FOV: 45 degrees
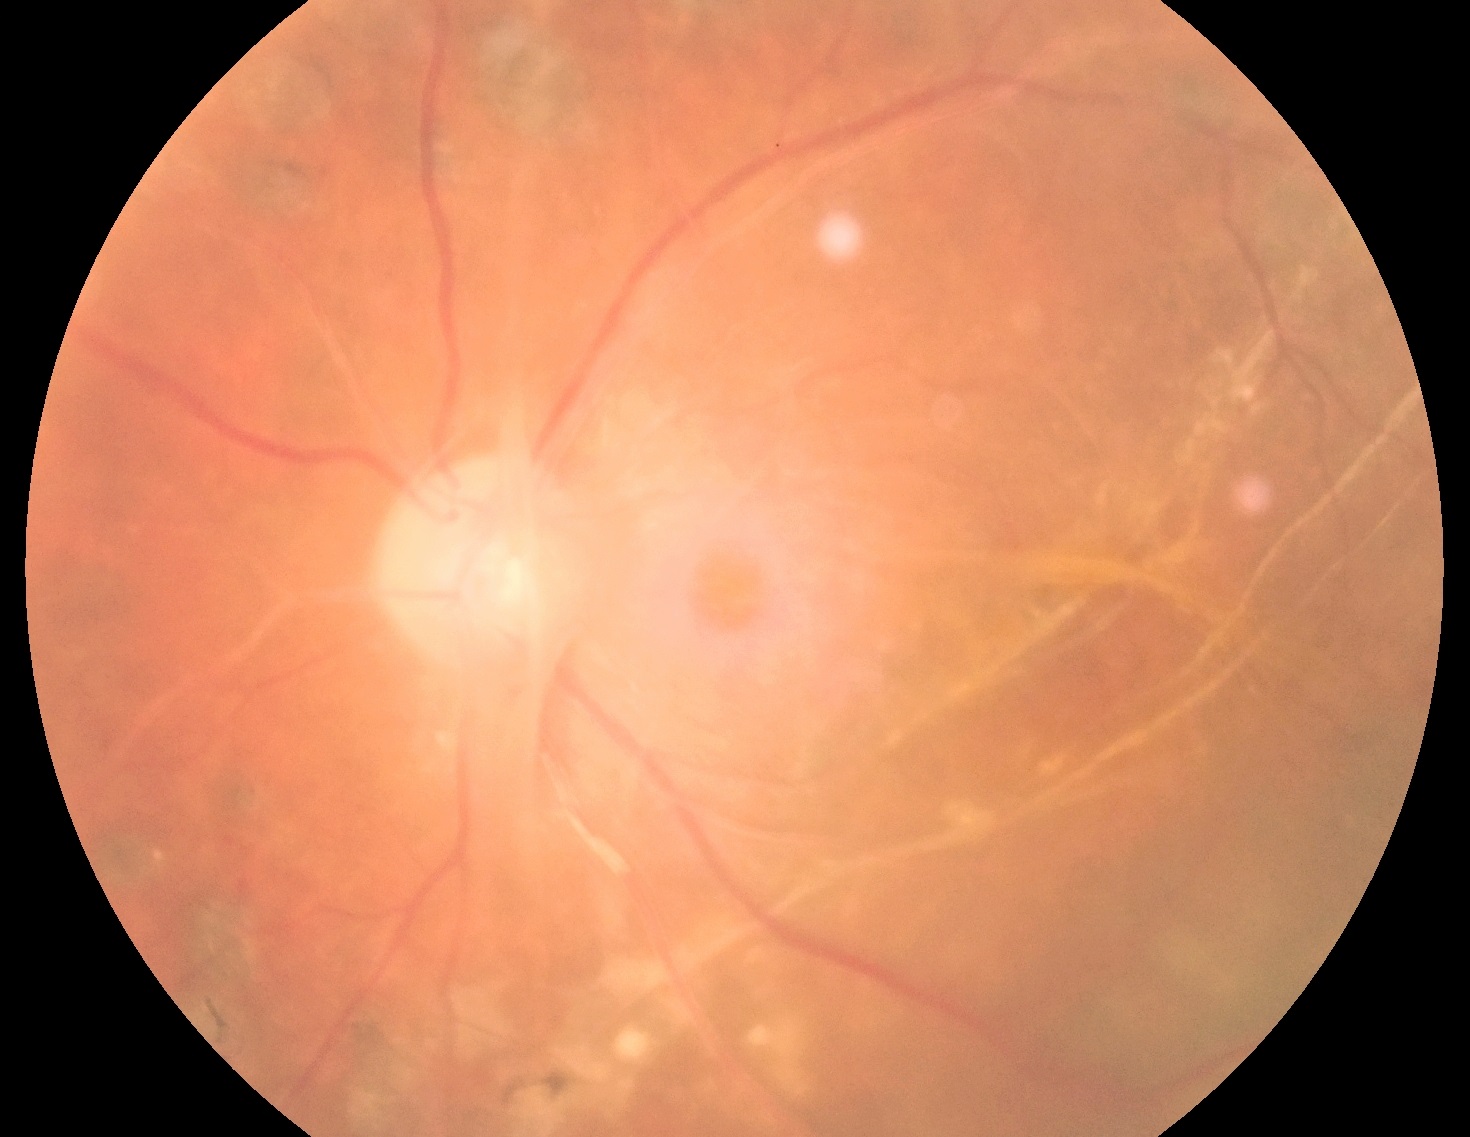

The retinopathy is classified as proliferative diabetic retinopathy.
Diabetic retinopathy grade: 4.